45° field of view:
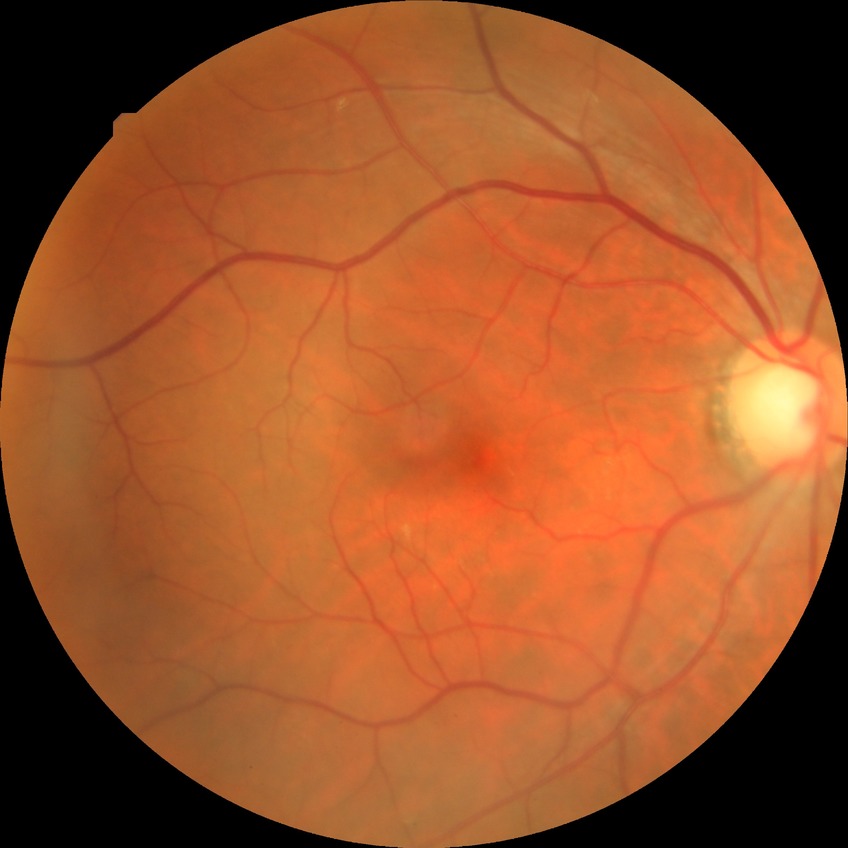 Modified Davis grading is no diabetic retinopathy.